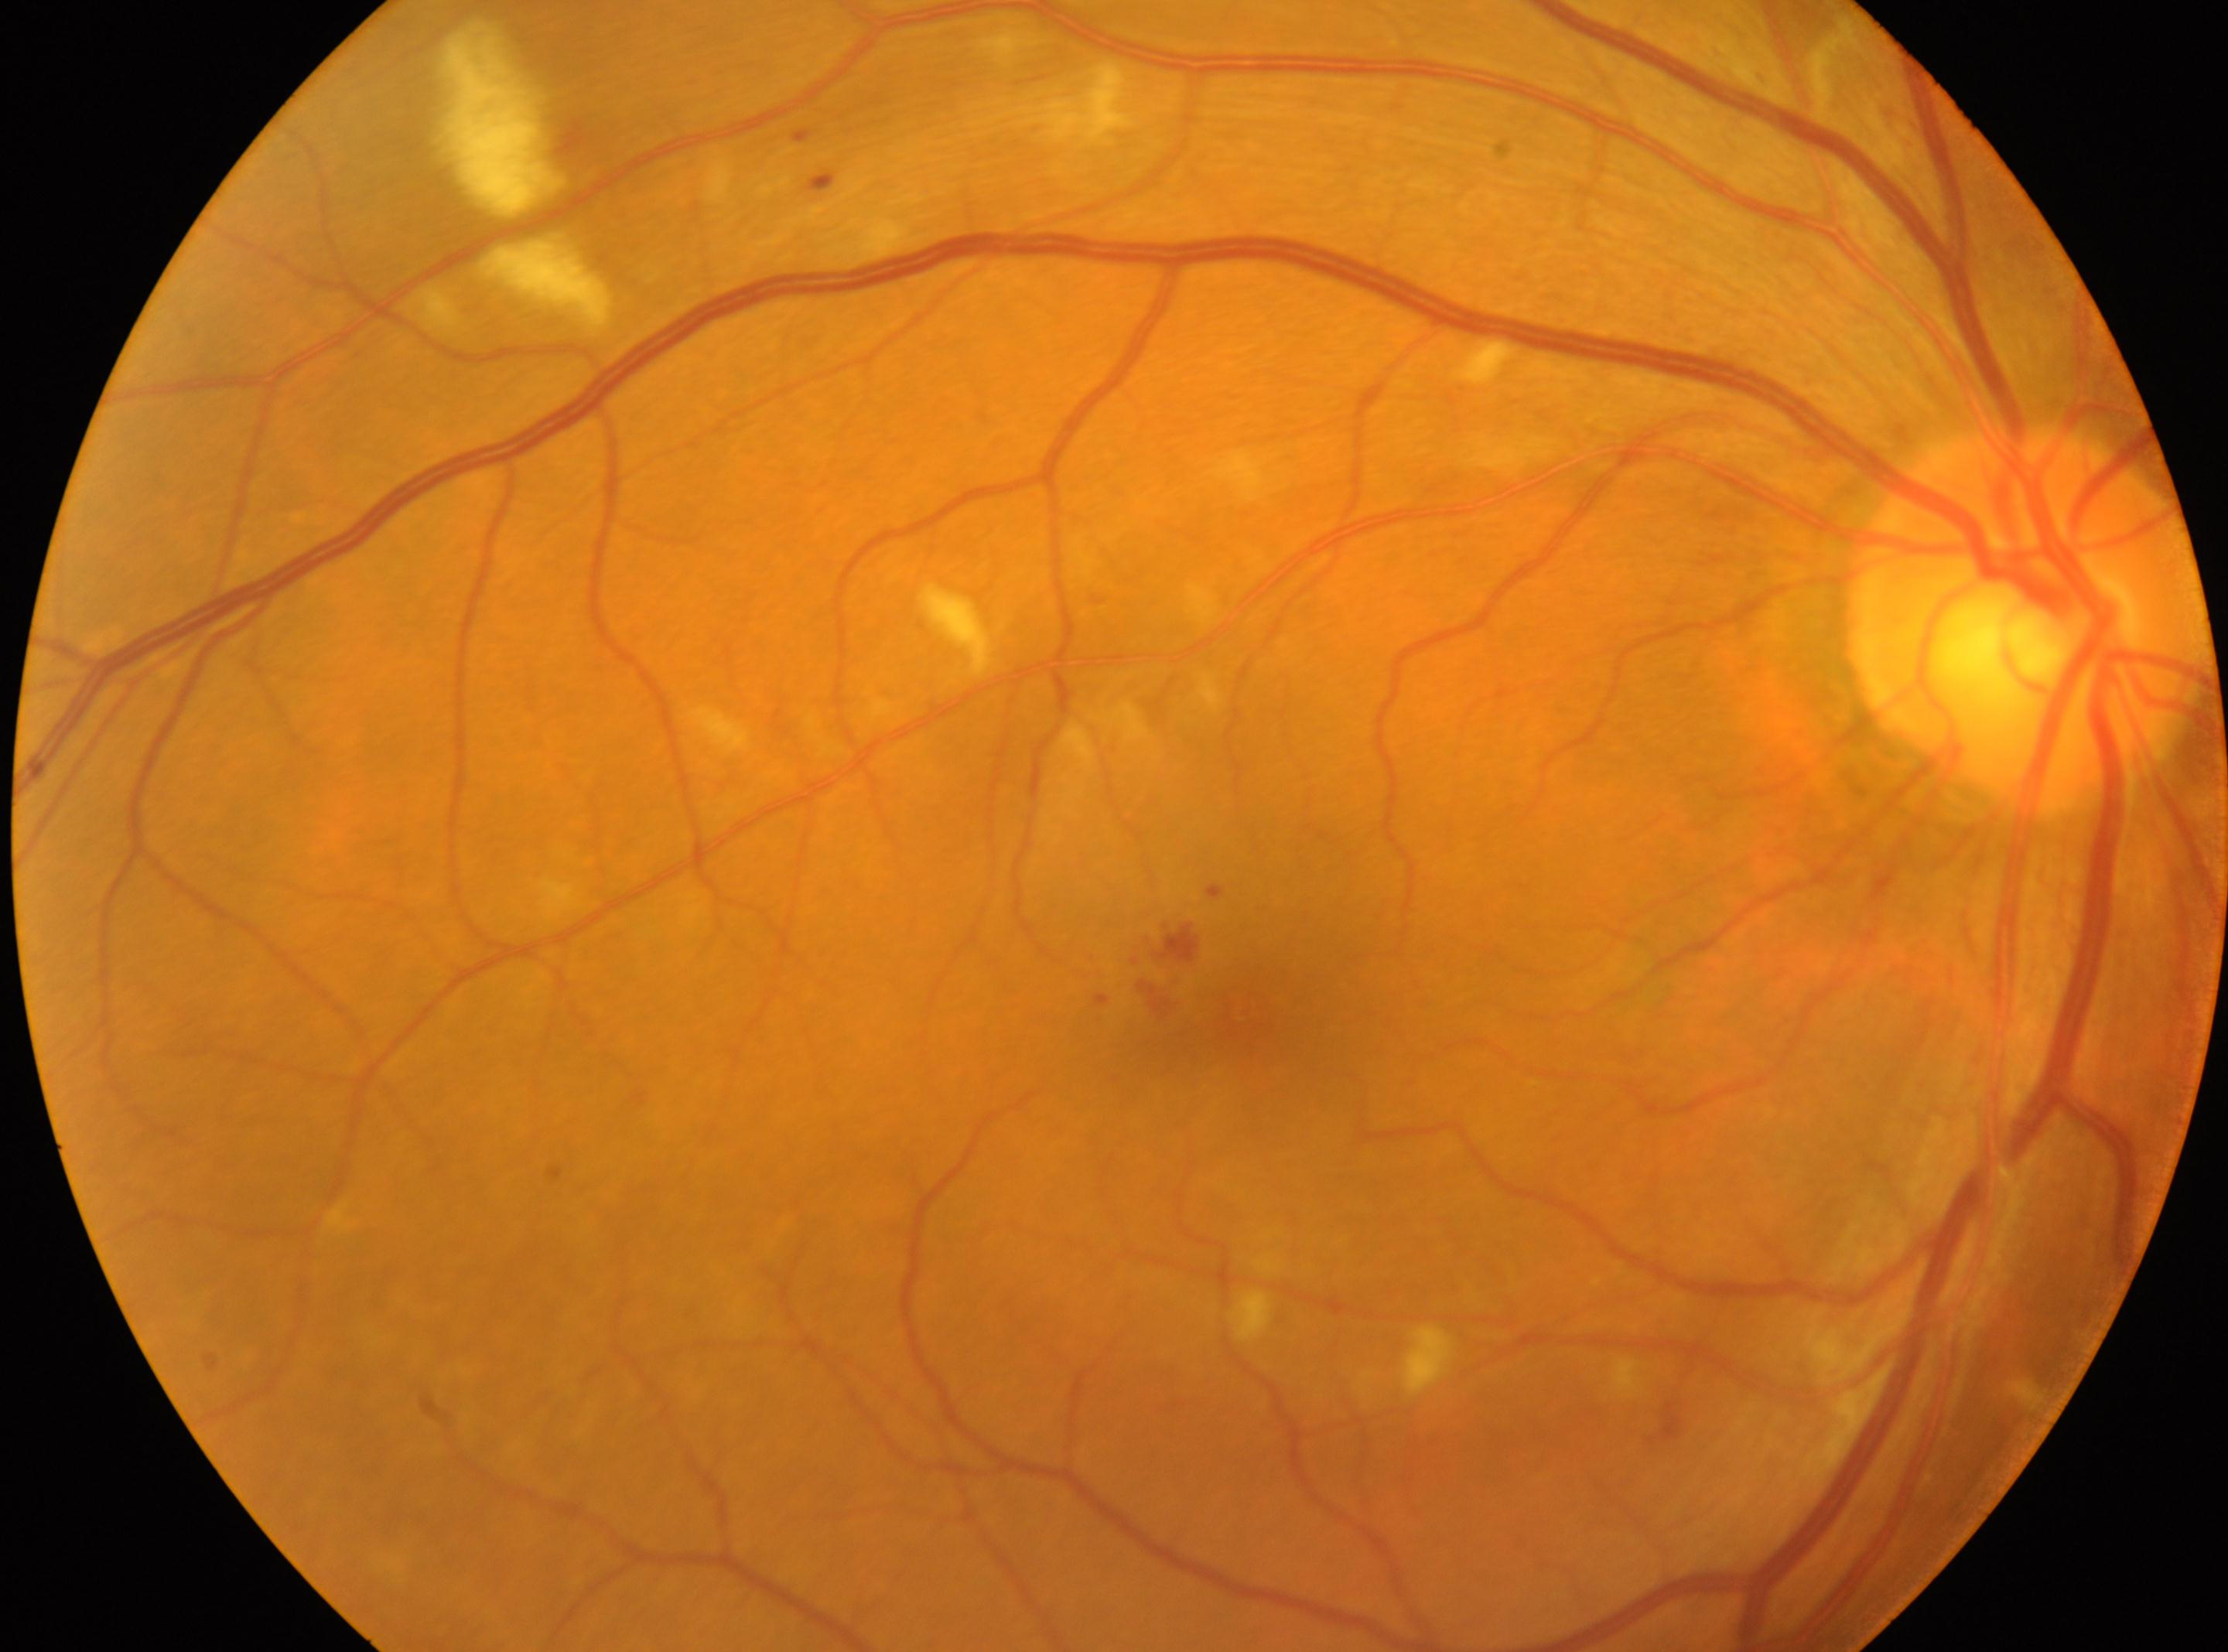 dr_category: non-proliferative diabetic retinopathy
eye: OD
optic_disc: (x=2032, y=620)
dr_grade: 2 (moderate NPDR)
fovea: (x=1242, y=1010)